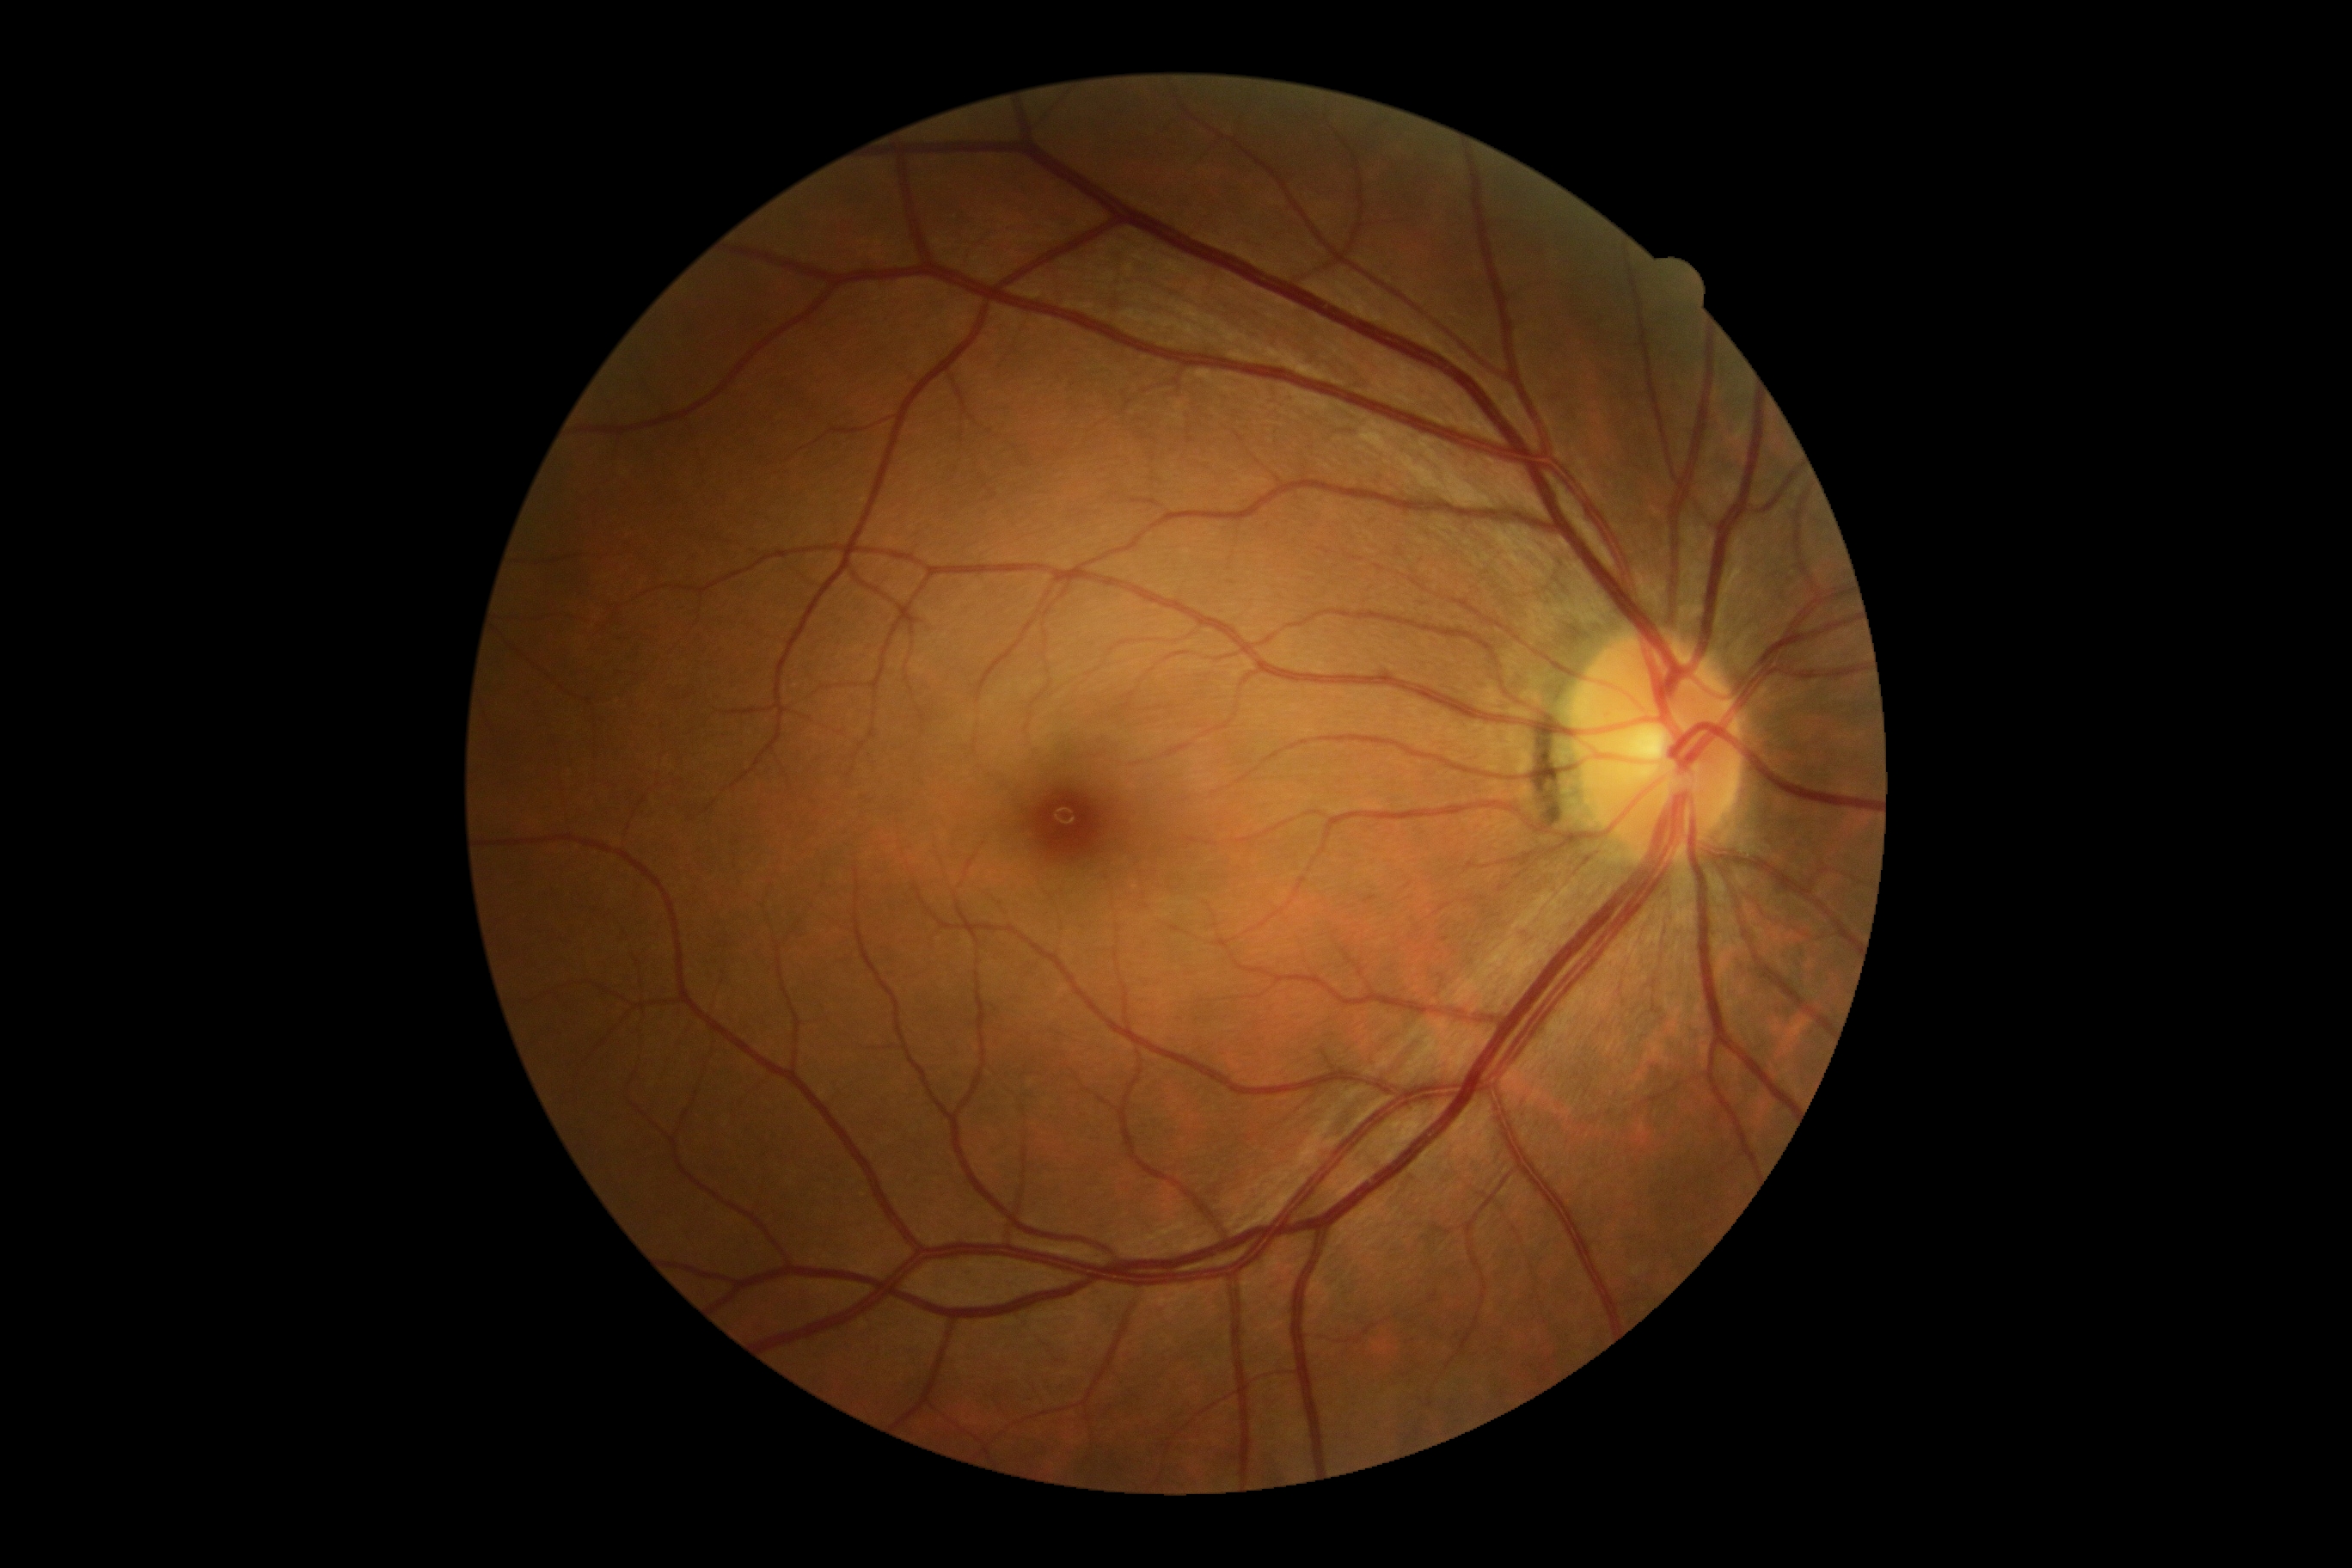 No DR findings. Diabetic retinopathy is 0.